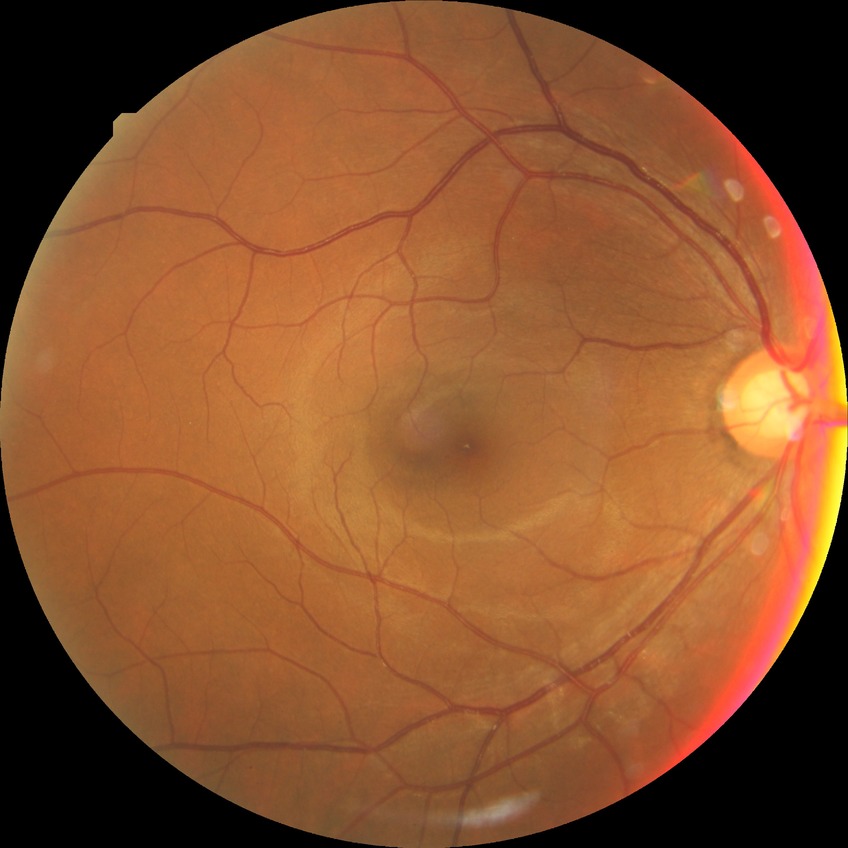

Retinopathy stage is no diabetic retinopathy.